NIDEK AFC-230 fundus camera; nonmydriatic; color fundus photograph; modified Davis classification.
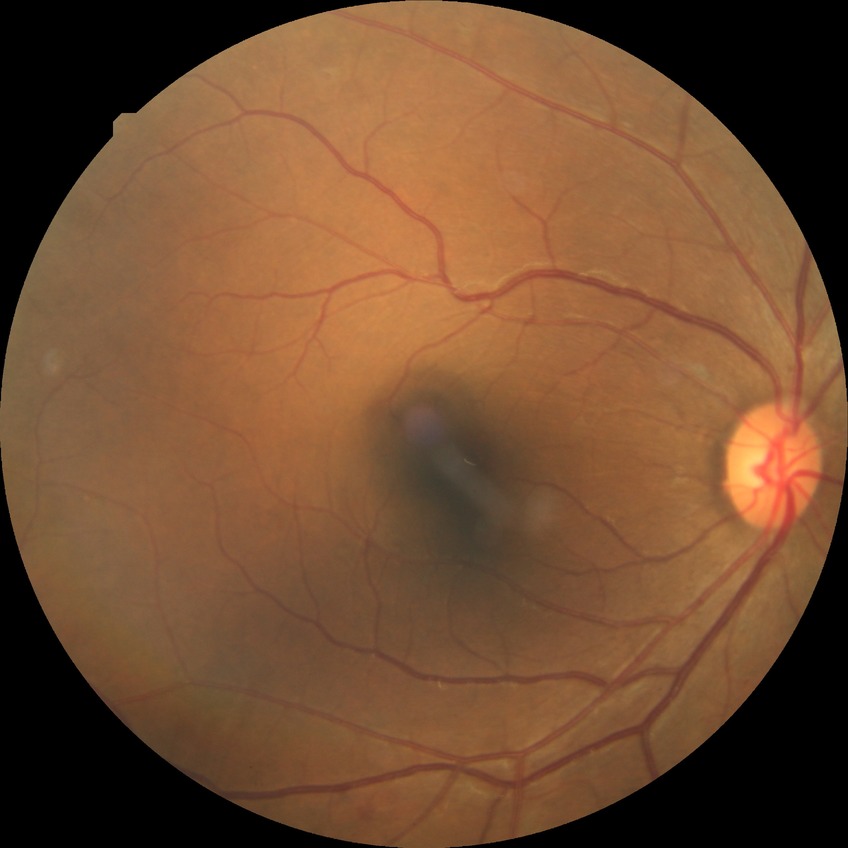 diabetic retinopathy stage: simple diabetic retinopathy.